45° FOV · color fundus image:
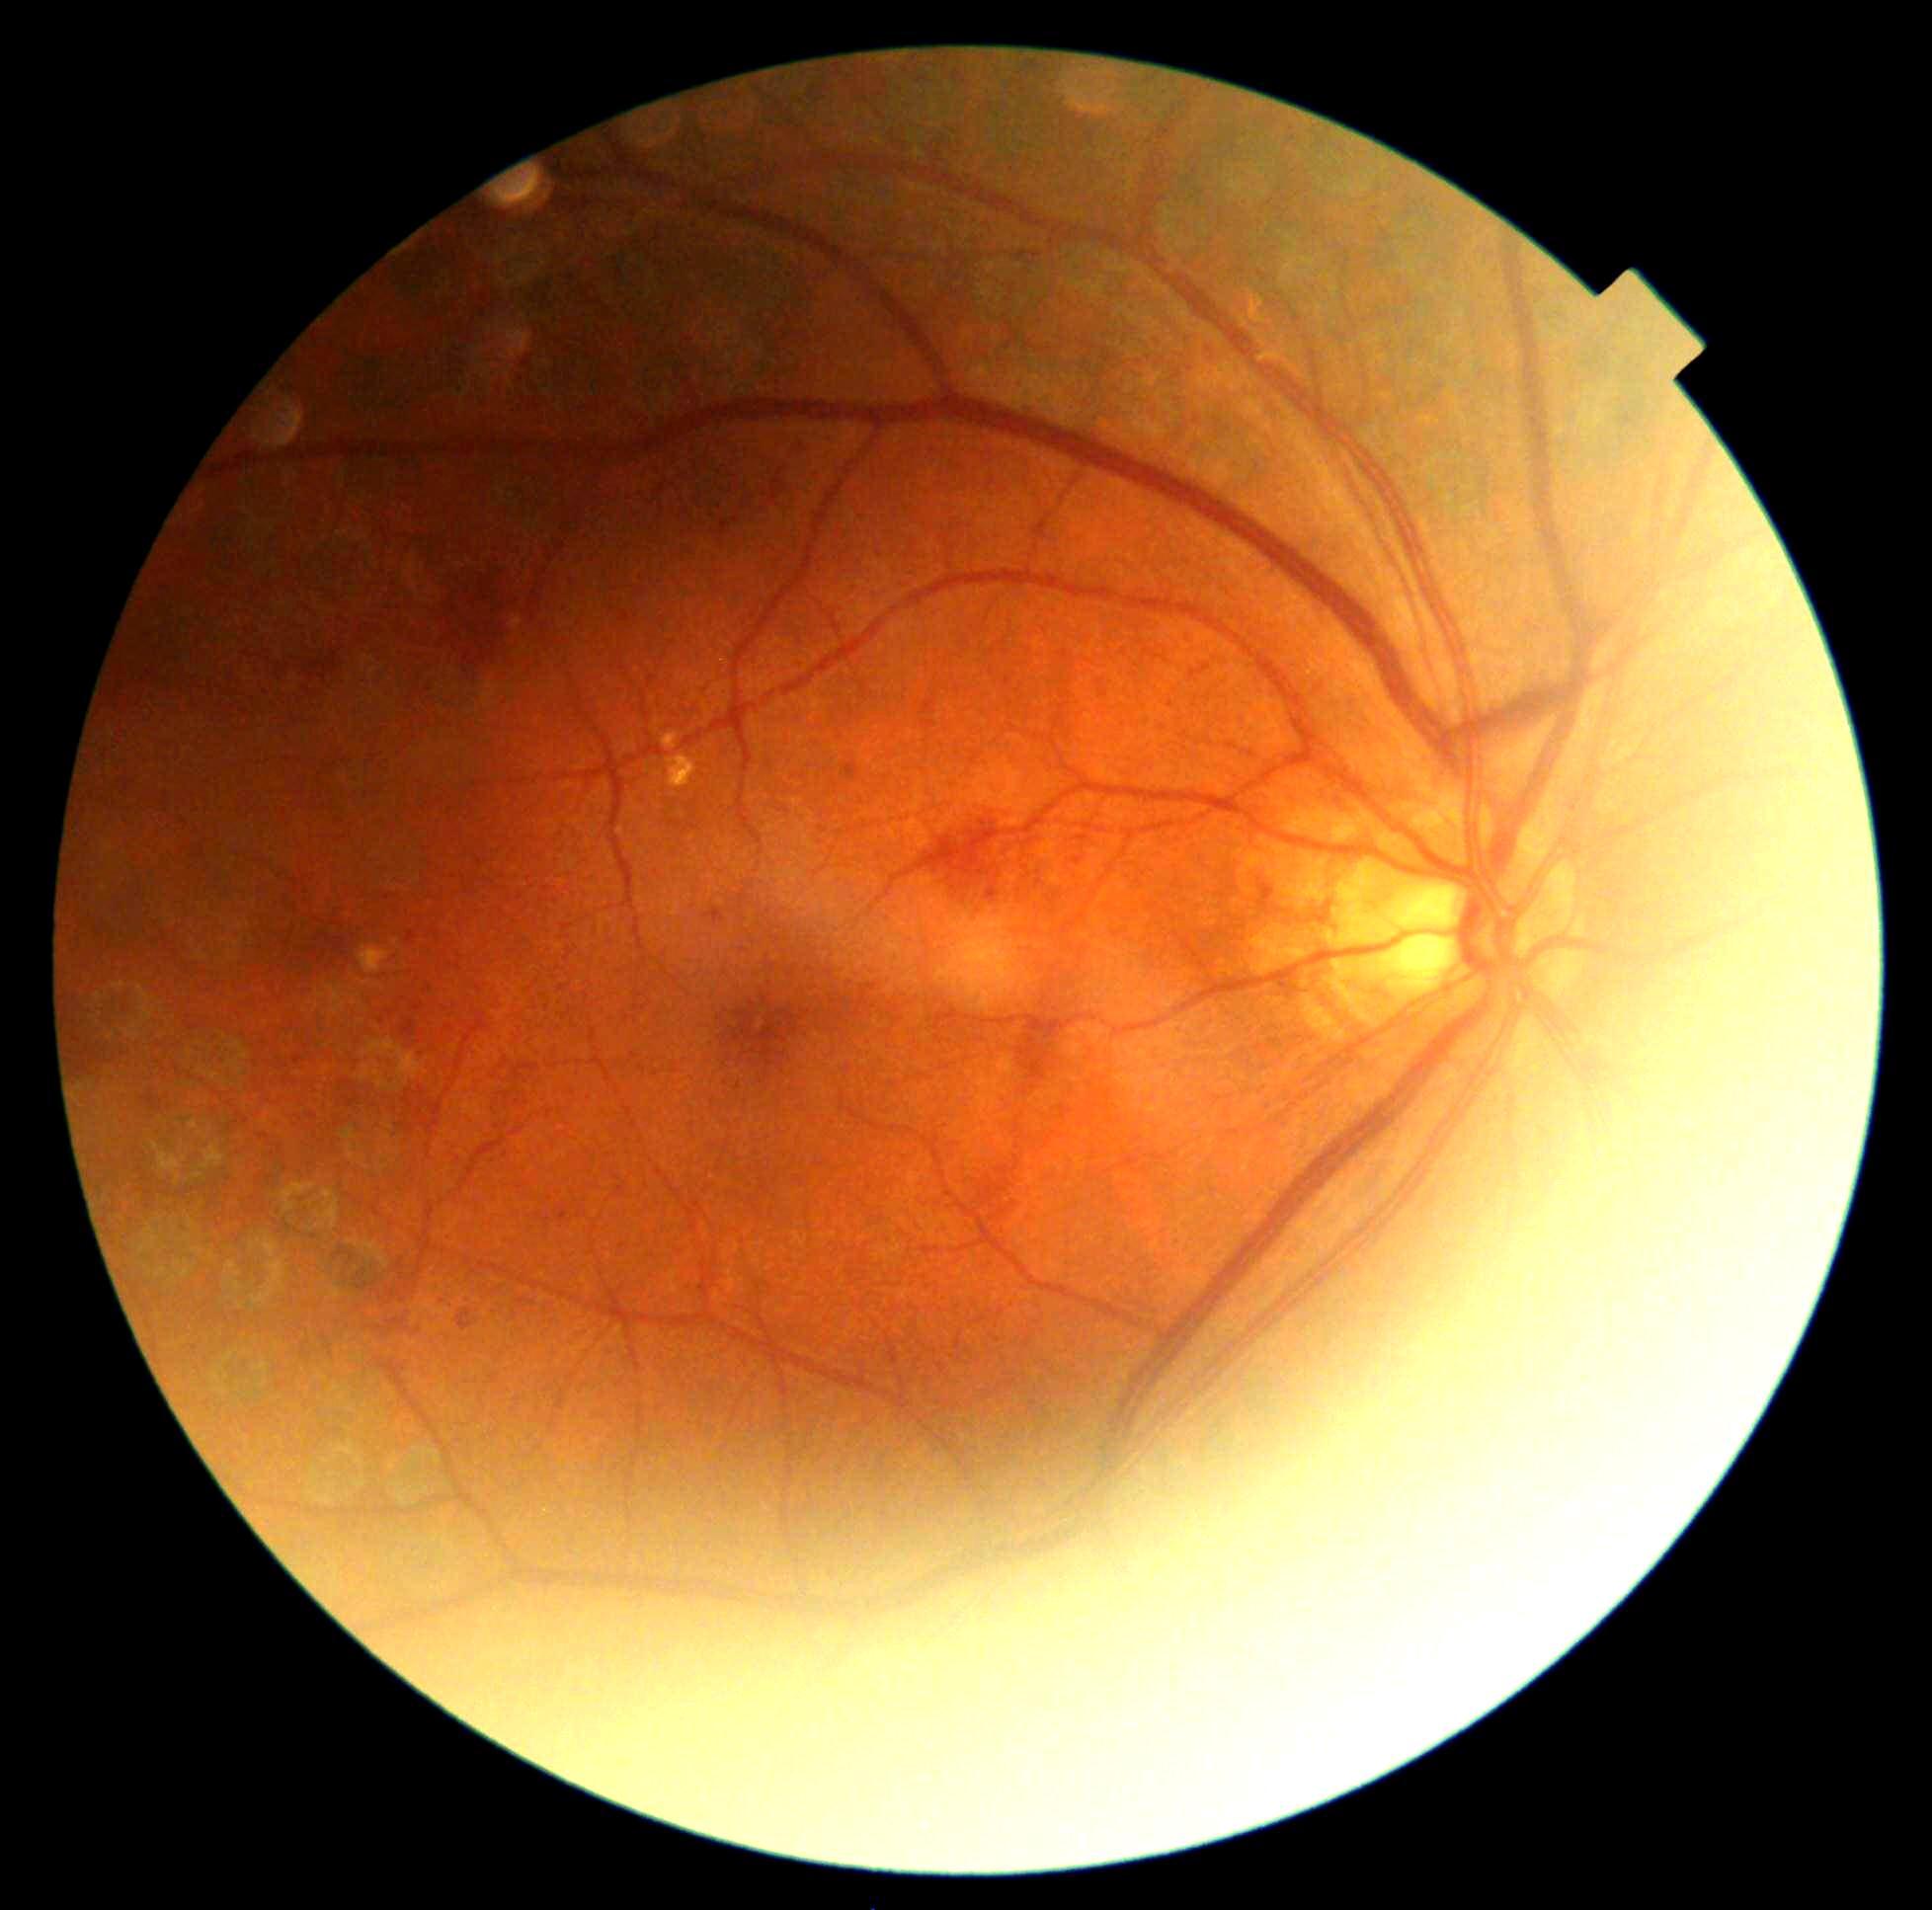

{
  "dr_grade": "2"
}